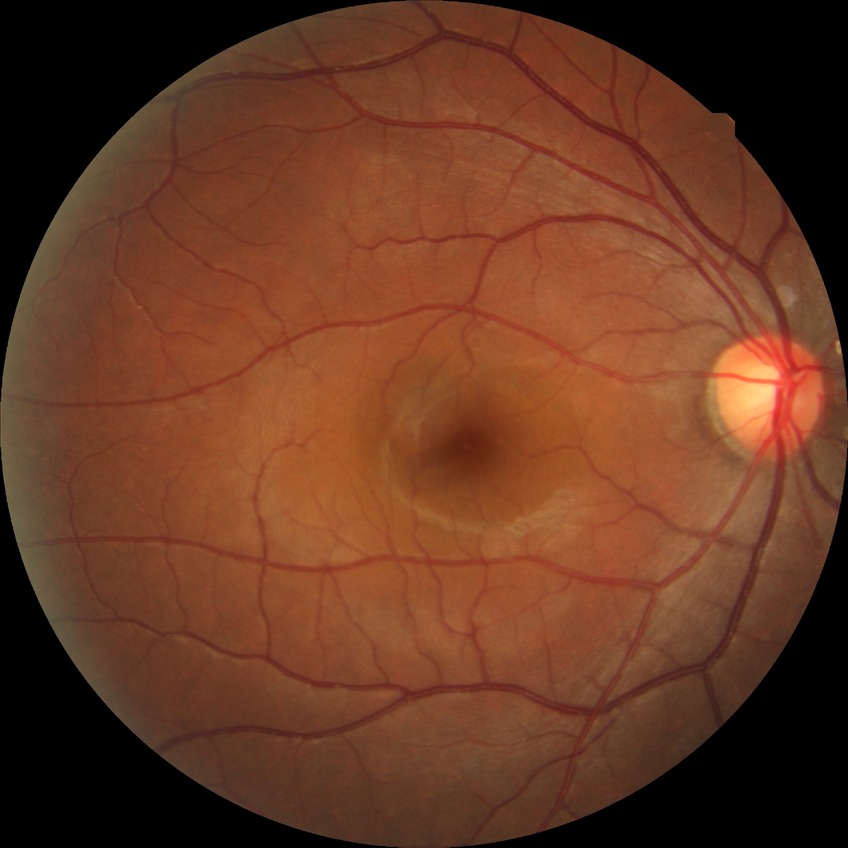
modified Davis grading@no diabetic retinopathy.